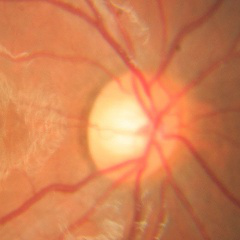
Q: Is glaucoma present?
A: No signs of glaucoma.